2352 by 1568 pixels, fundus photo, FOV: 45 degrees — 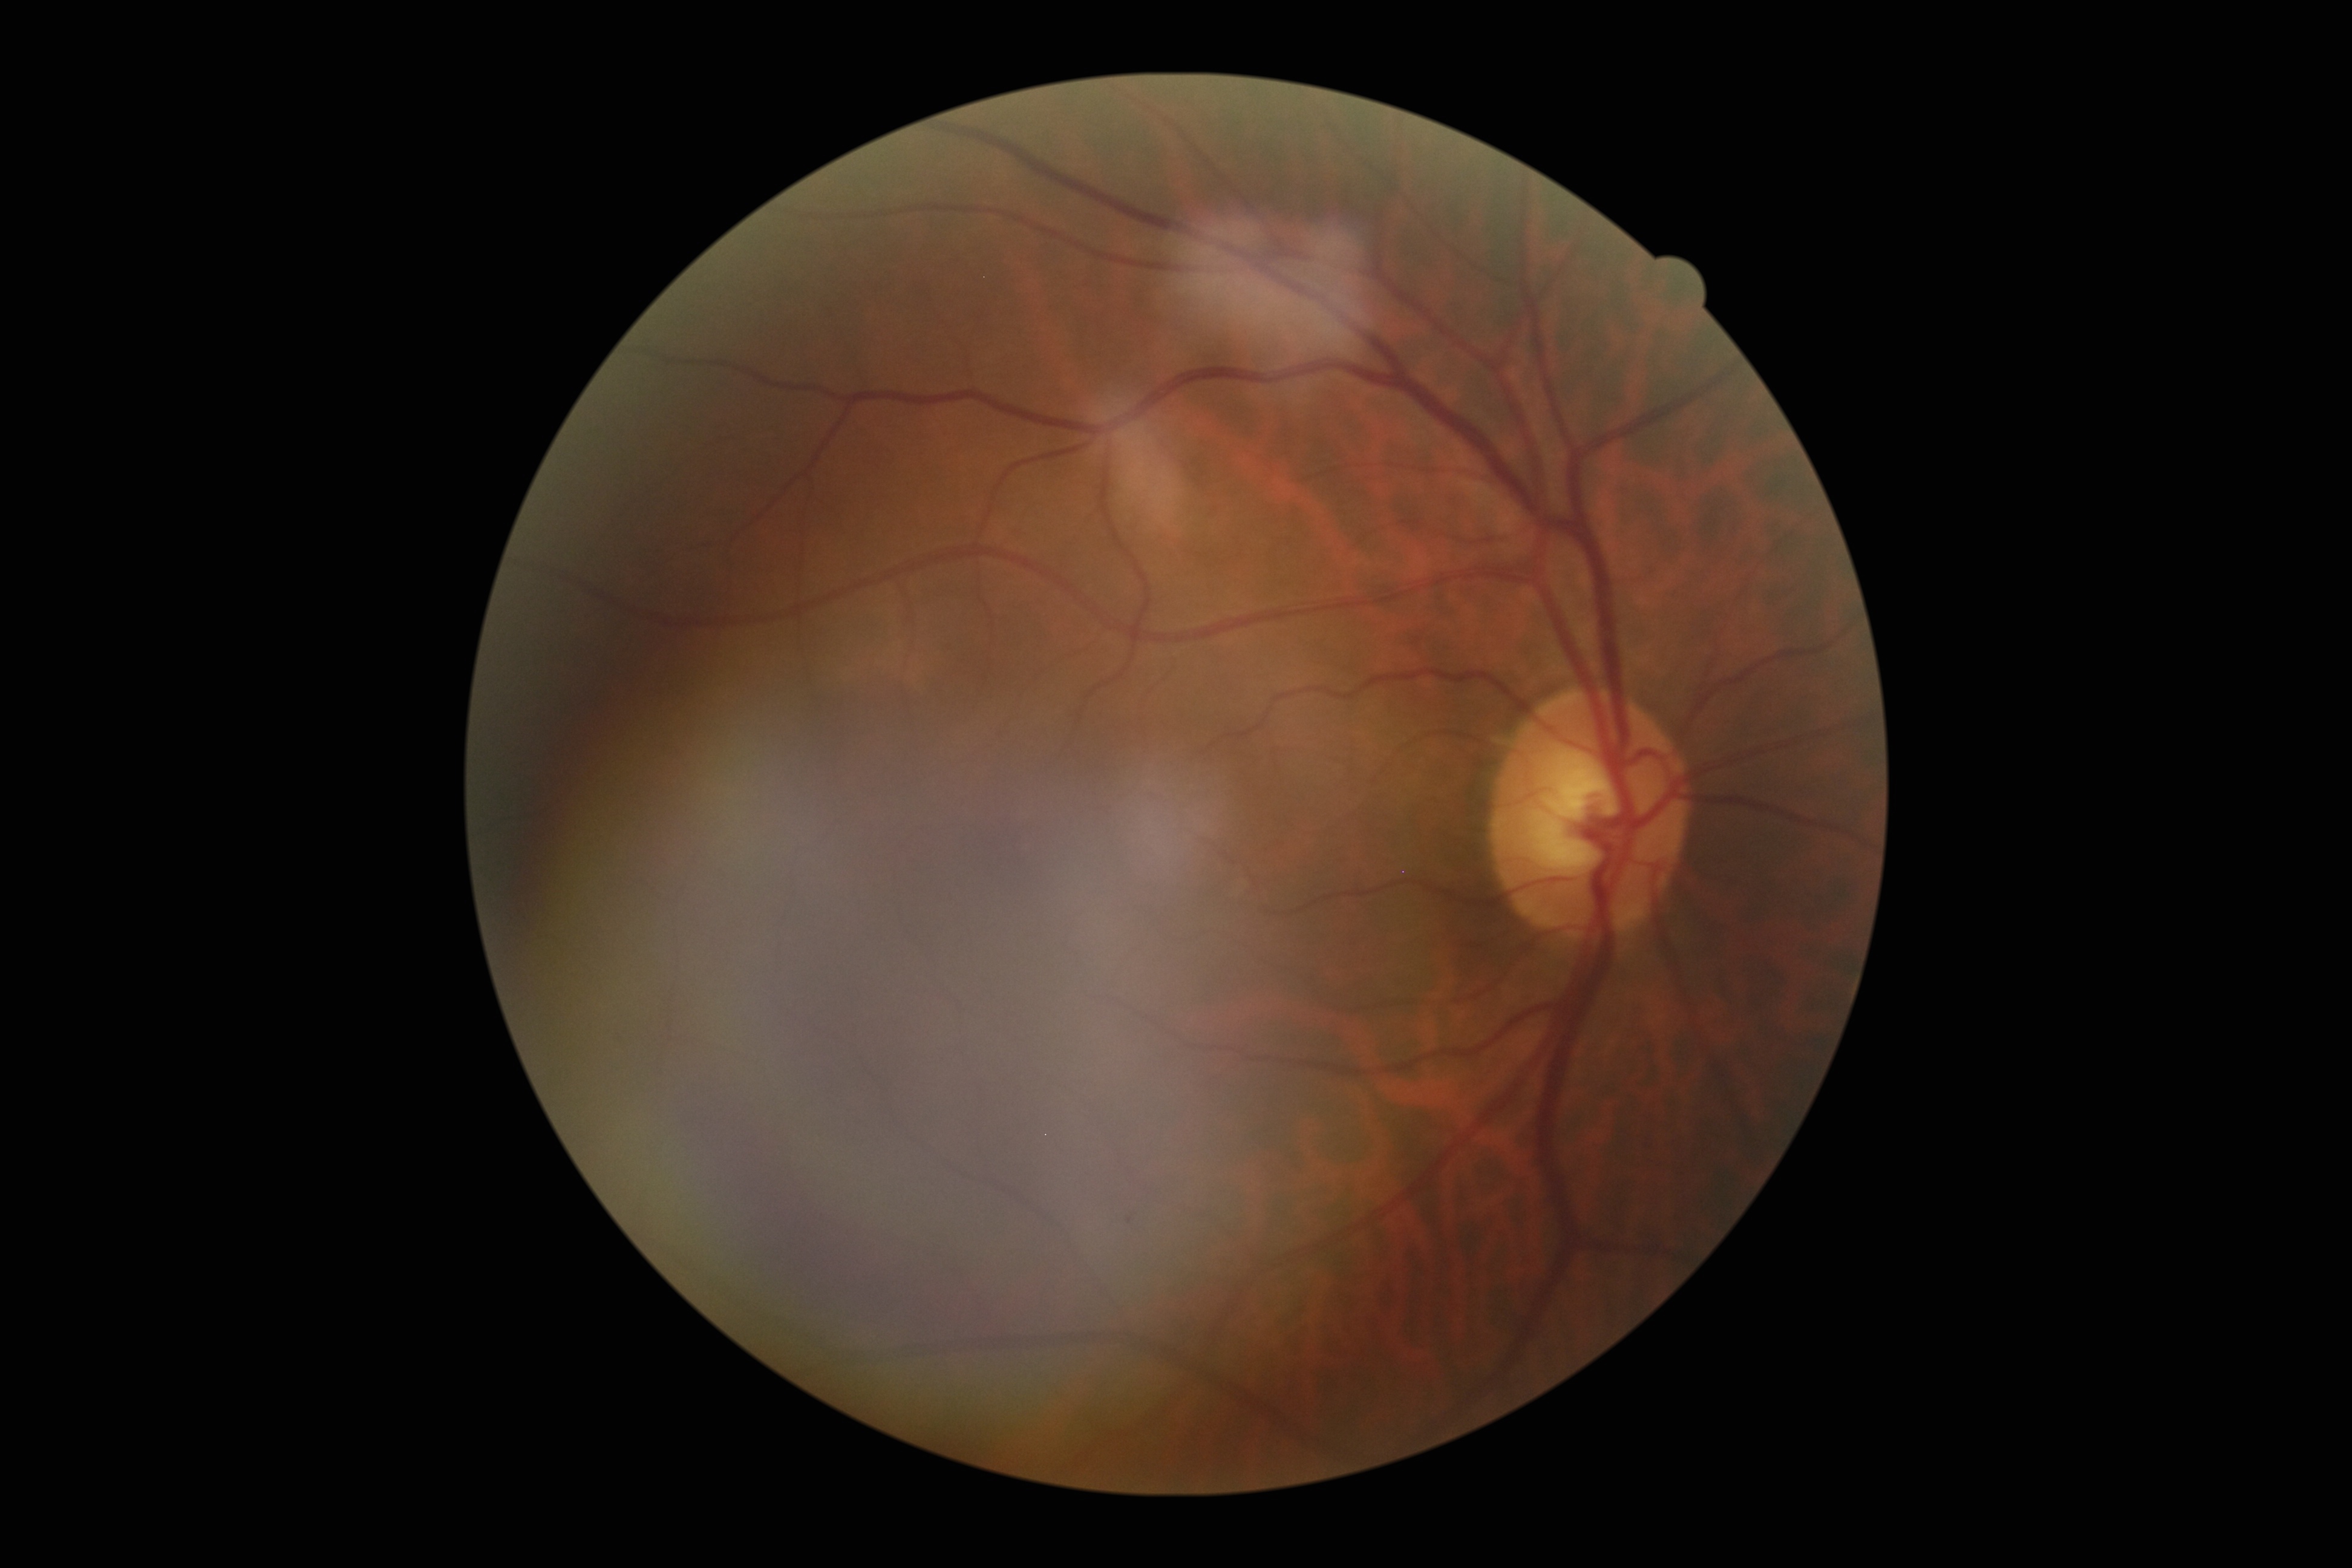
retinopathy grade@0/4, DR impression@negative for DR.